Phoenix ICON wide-field infant fundus image
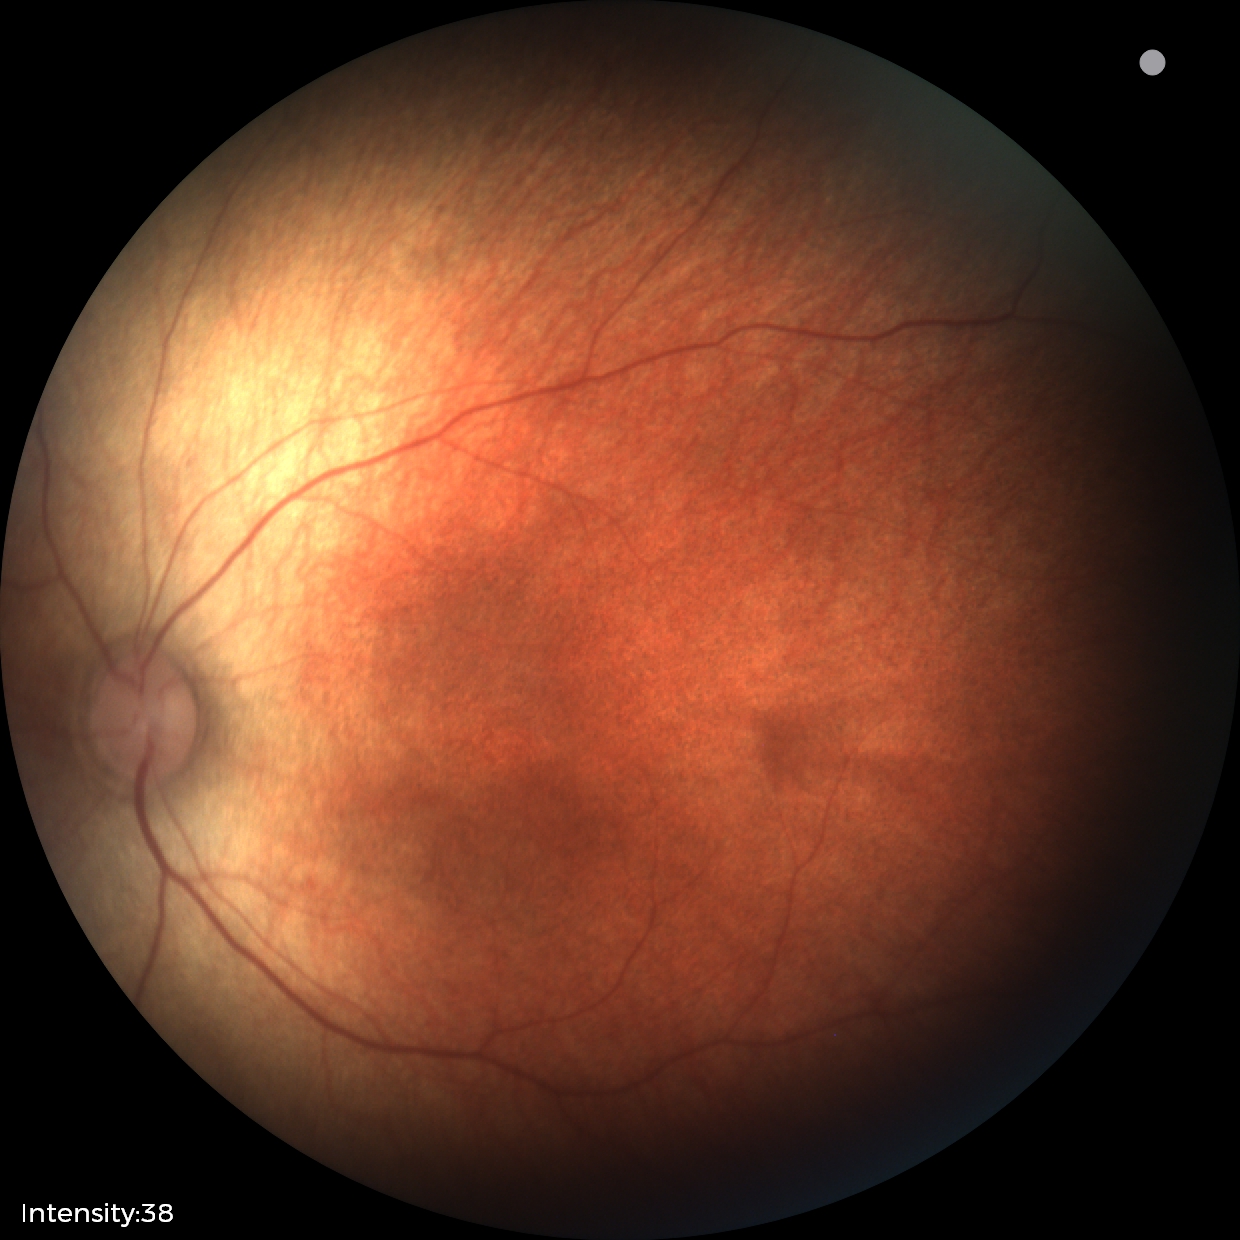 Q: What was the screening finding?
A: normal fundus examination